Graded on the modified Davis scale; 45° field of view; 848x848px: 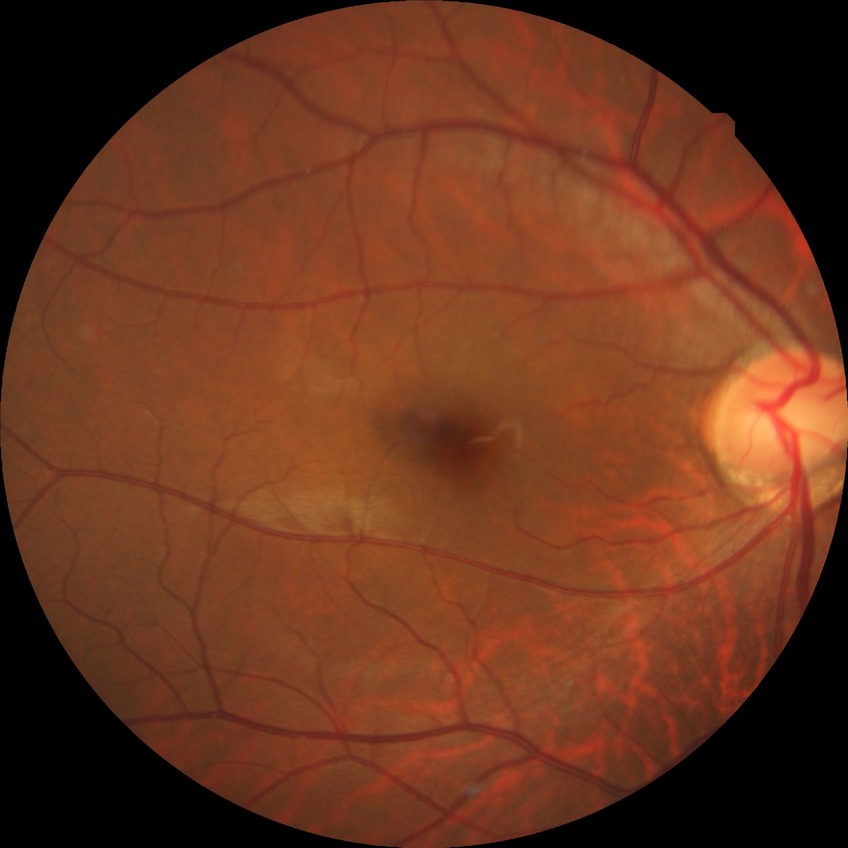 Davis DR grade = NDR